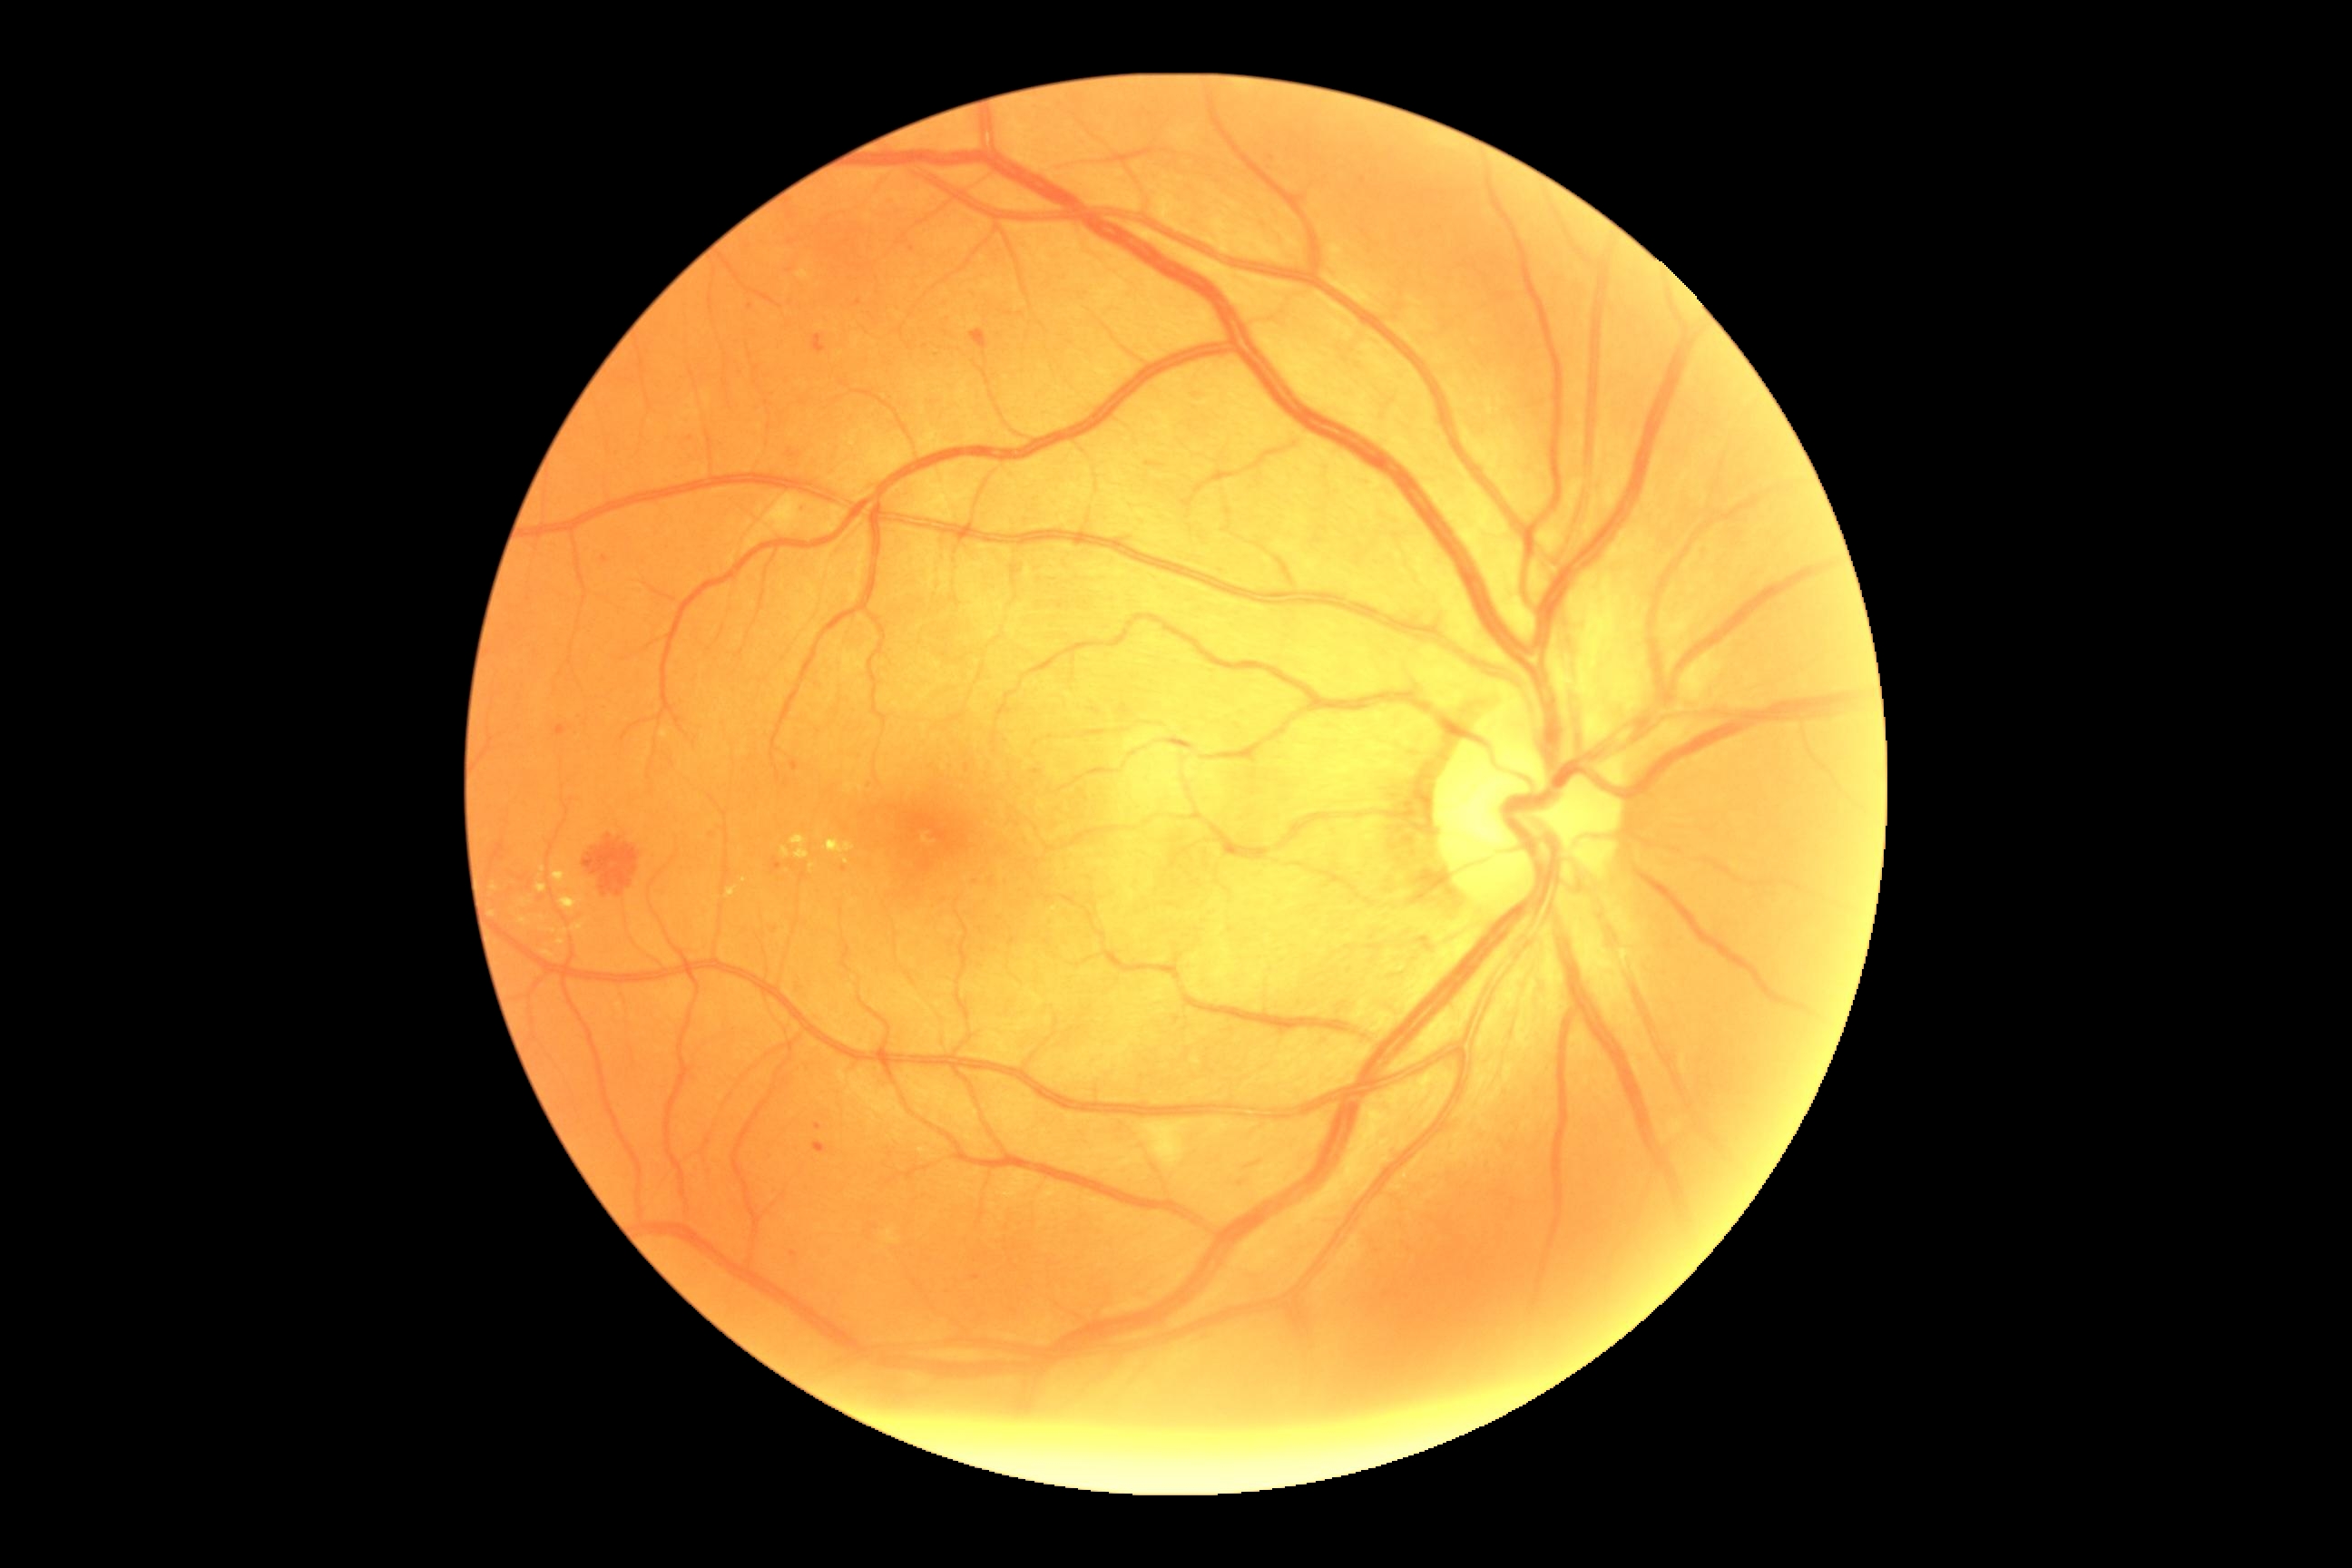
{"partial":true,"dr_grade":2,"dr_grade_name":"moderate NPDR","lesions":{"ma":[[556,725,567,736],[790,761,799,772],[814,1124,823,1130],[790,1251,798,1257],[602,556,611,564],[772,858,783,872],[1032,770,1043,776],[814,1142,827,1153]],"ma_small_centers":[[690,439],[1364,180],[790,271],[790,216],[1271,159],[792,241],[913,249],[751,306],[859,303],[775,930],[844,869],[1178,1020]],"se":[[776,496,796,531],[1142,1121,1191,1170]],"he":[[781,447,803,471],[970,329,988,351],[1235,1179,1250,1188],[1146,462,1164,469],[812,335,827,355],[583,836,640,897],[1235,1161,1257,1173]],"ex":[[520,899,533,908],[554,872,564,885],[556,939,565,946],[825,839,856,854],[727,888,736,897],[808,865,816,872],[520,917,531,926],[781,848,790,858],[571,917,589,934],[542,950,554,959],[790,836,808,861],[536,885,547,894],[562,903,574,914]],"ex_small_centers":[[566,933],[494,887],[553,932],[542,918],[493,914],[847,862]]}}